848x848; DR severity per modified Davis staging
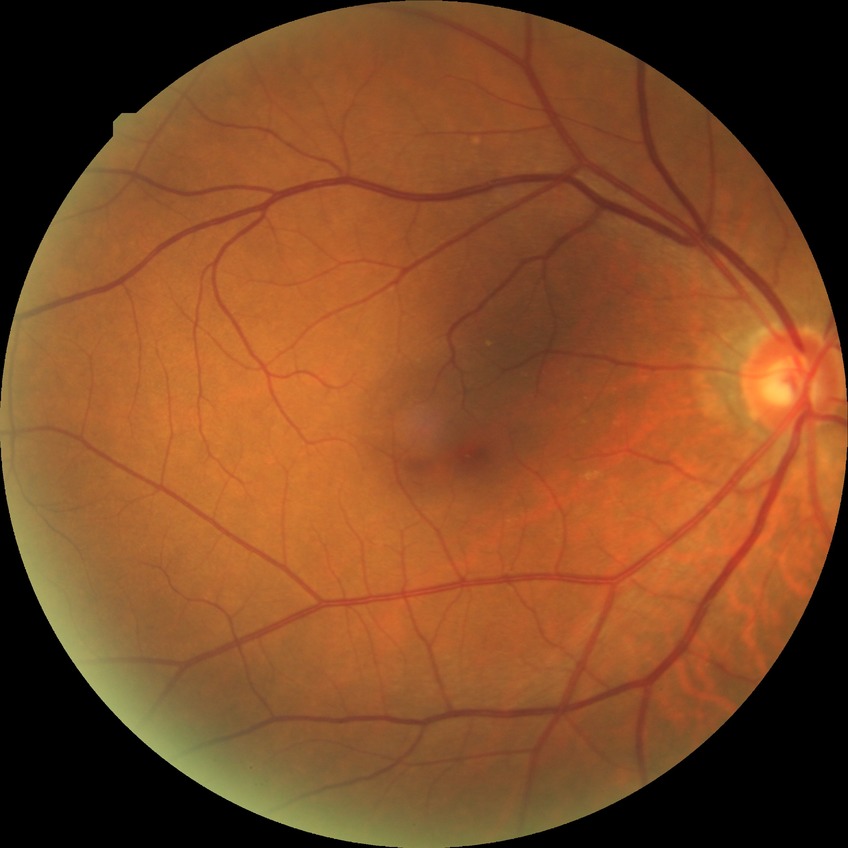
Diabetic retinopathy (DR): no diabetic retinopathy (NDR).